Image size 2212x1659.
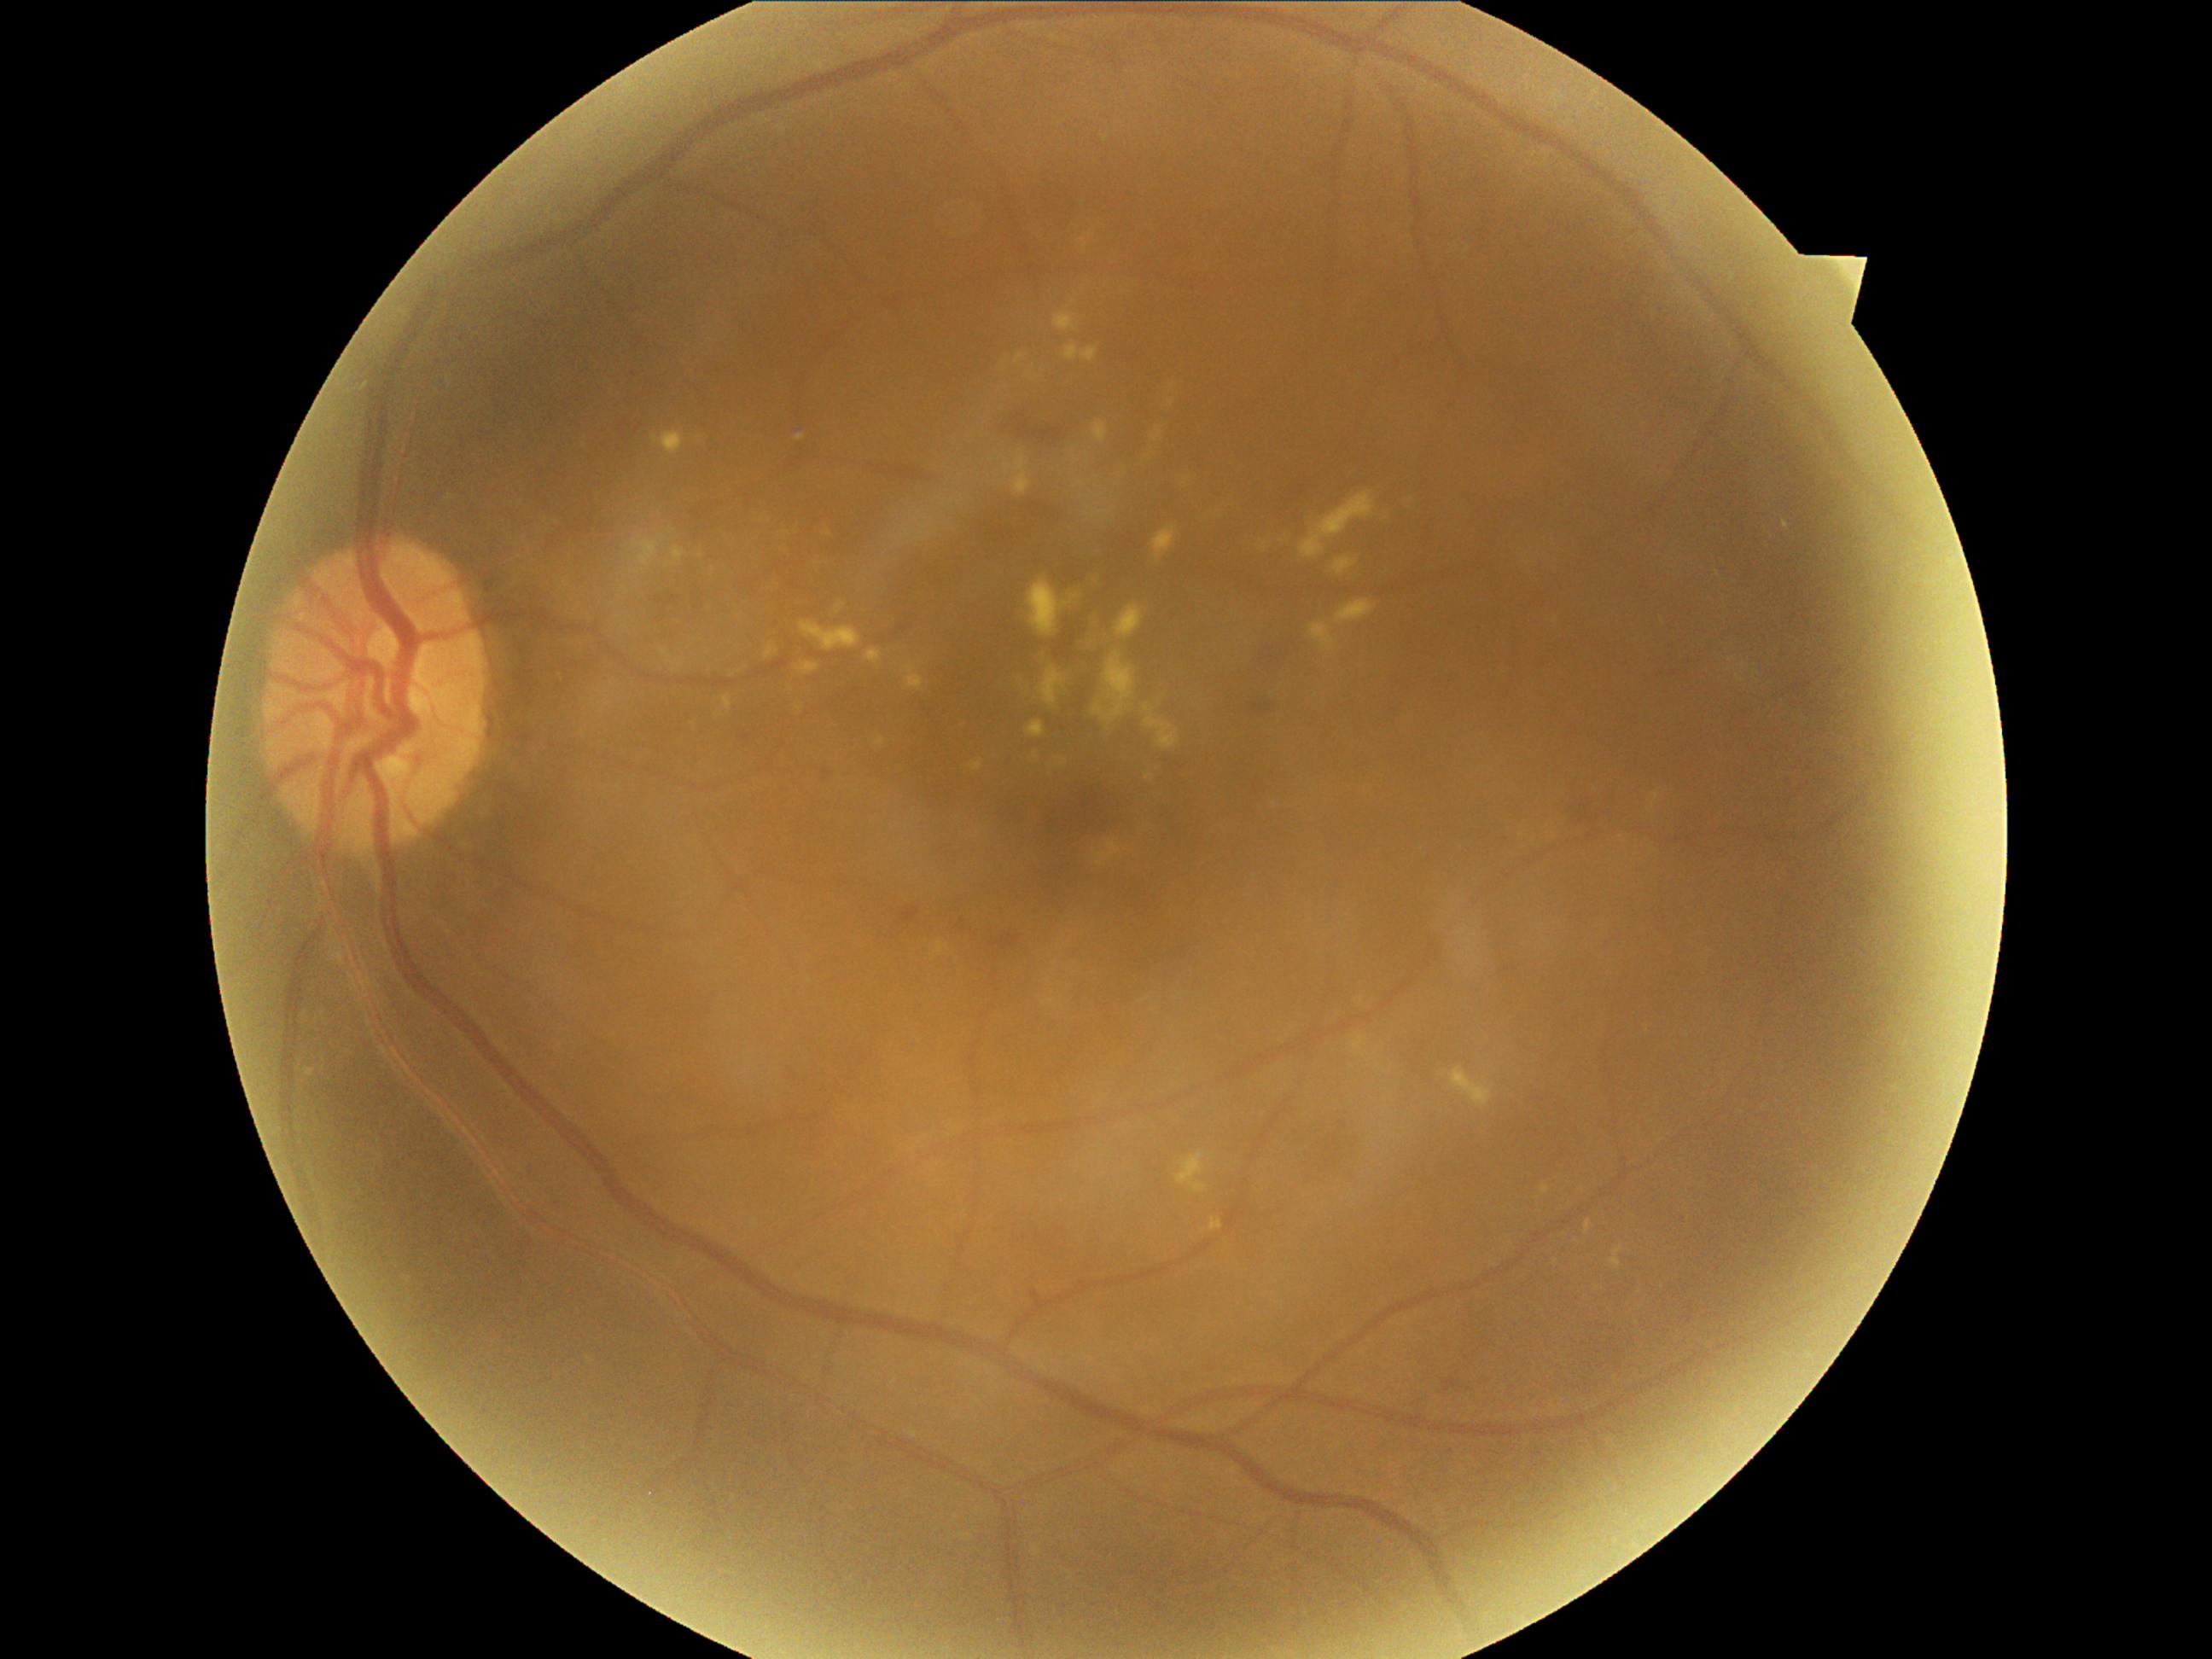 Diabetic retinopathy (DR) is grade 2 (moderate NPDR).